Fundus photo, 2352 x 1568 pixels, 45° field of view.
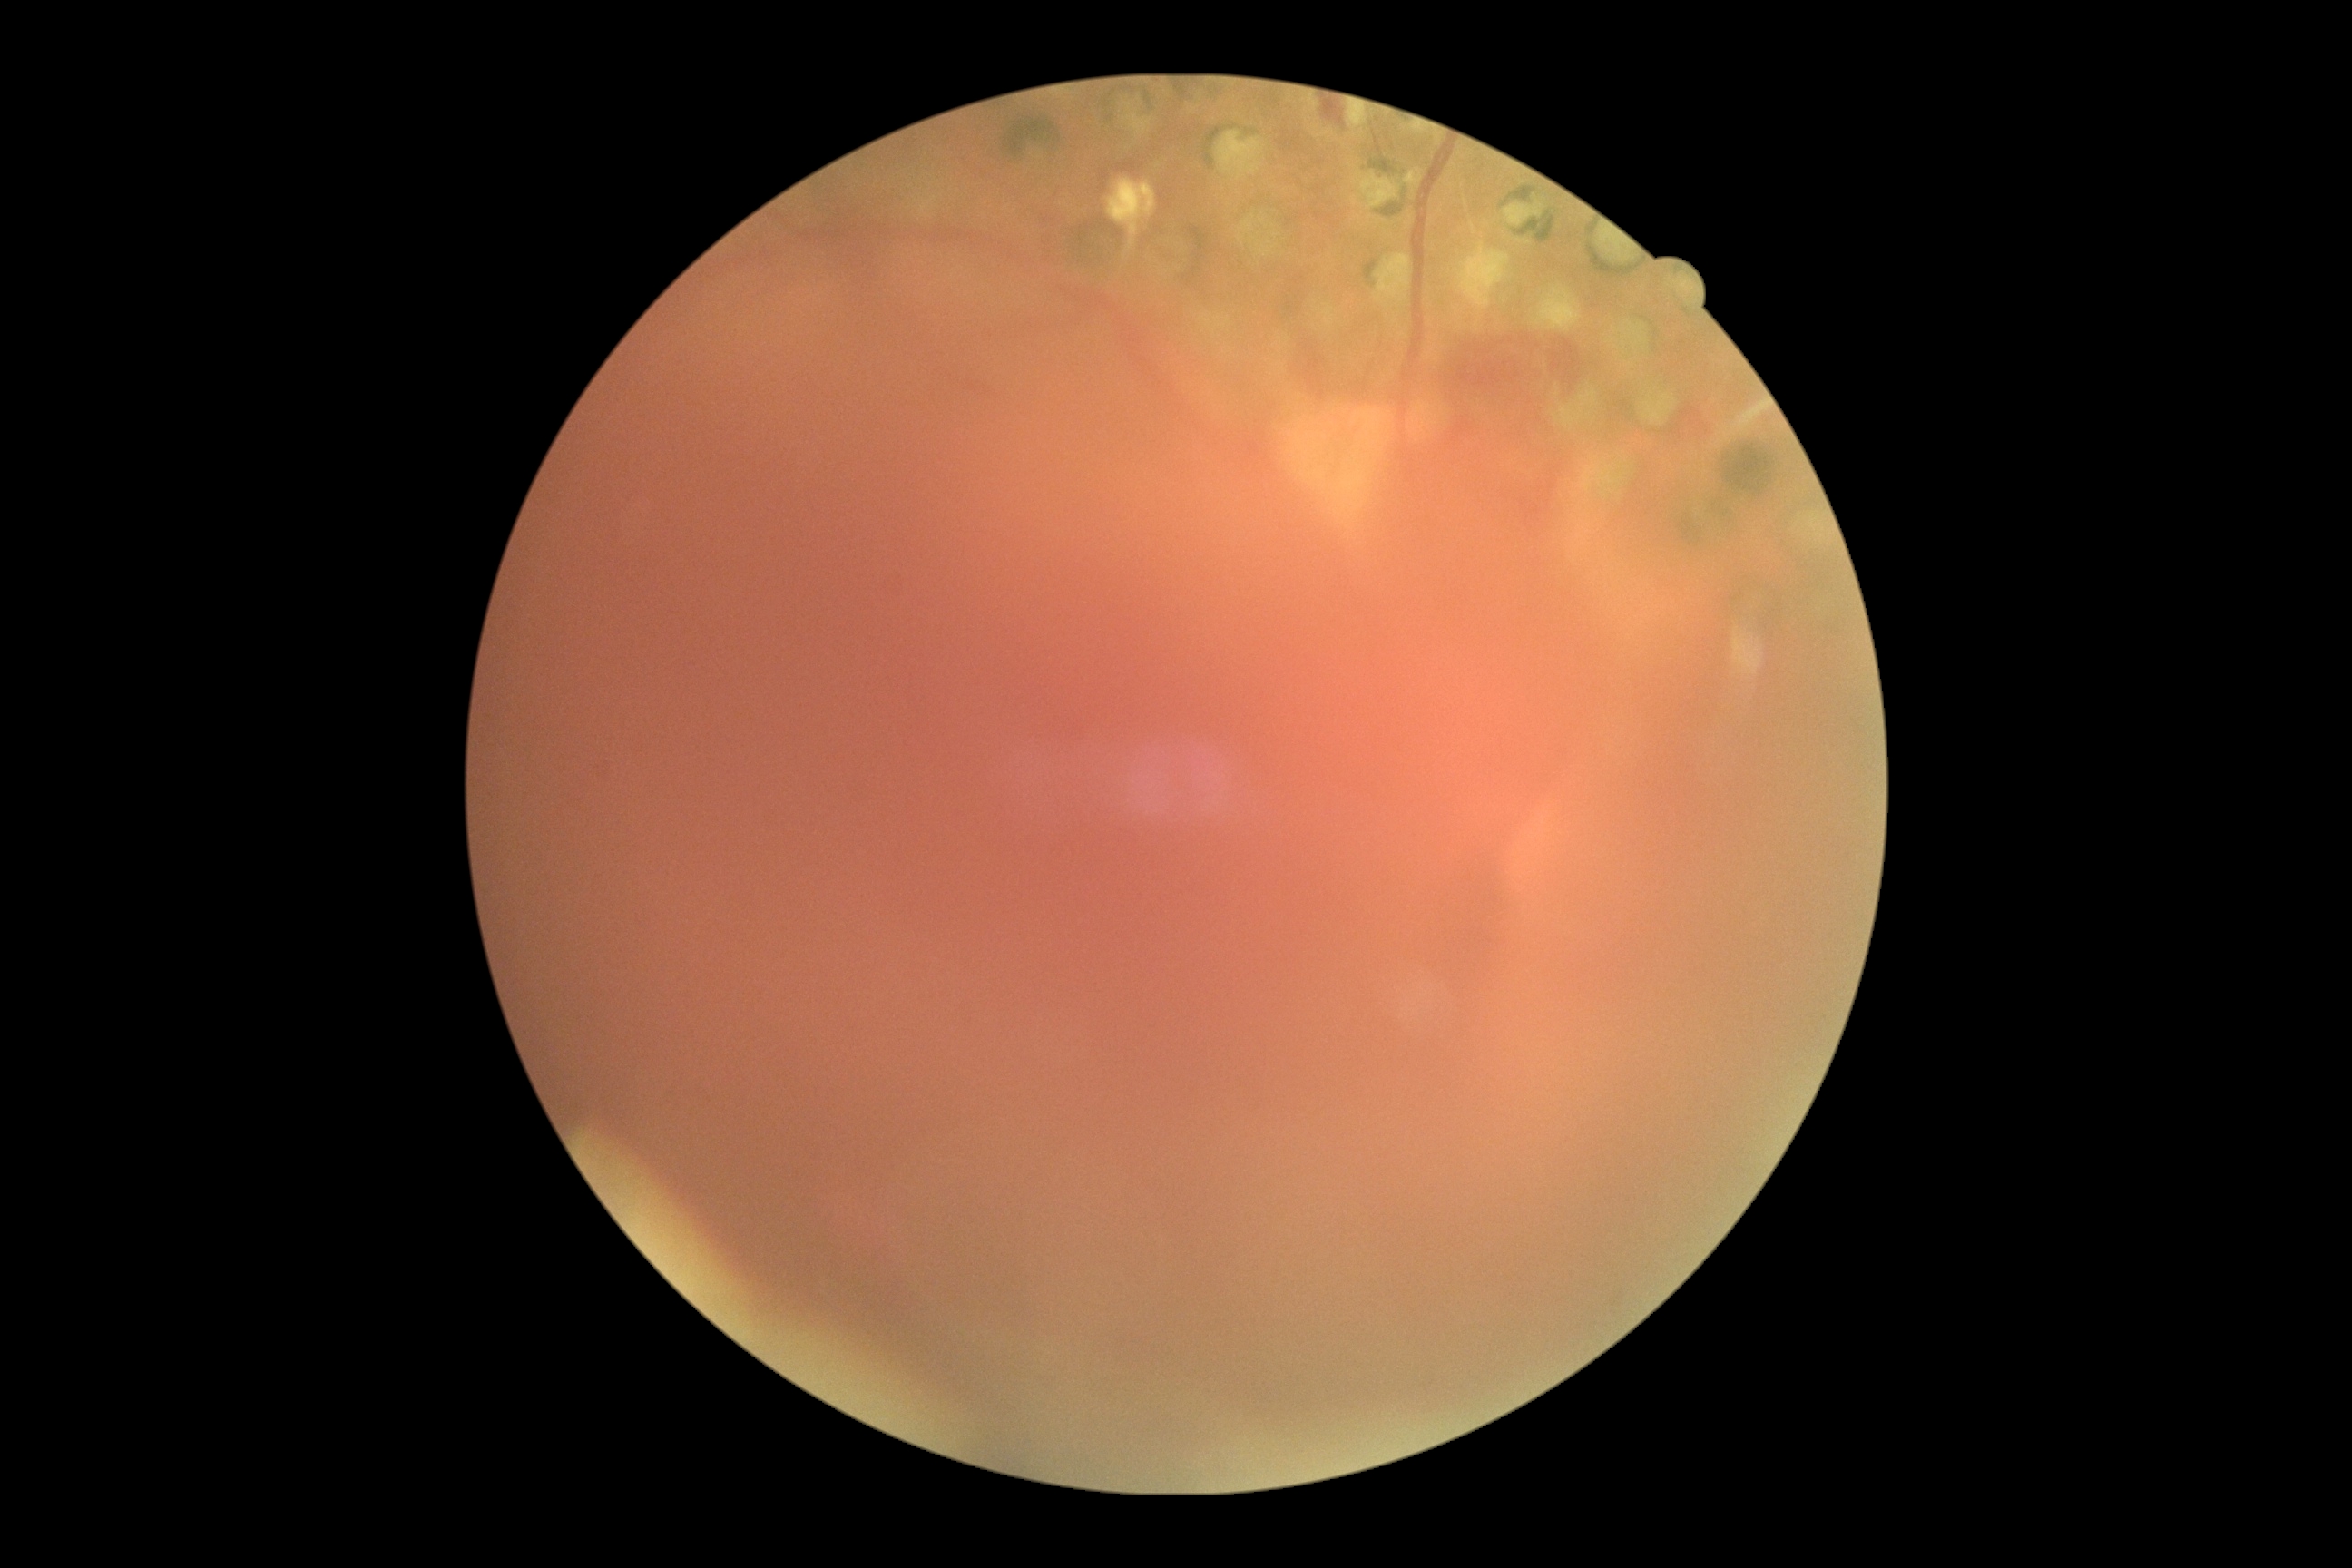 DR class: proliferative diabetic retinopathy; DR: 4/4.